45 degree fundus photograph · camera: NIDEK AFC-230: 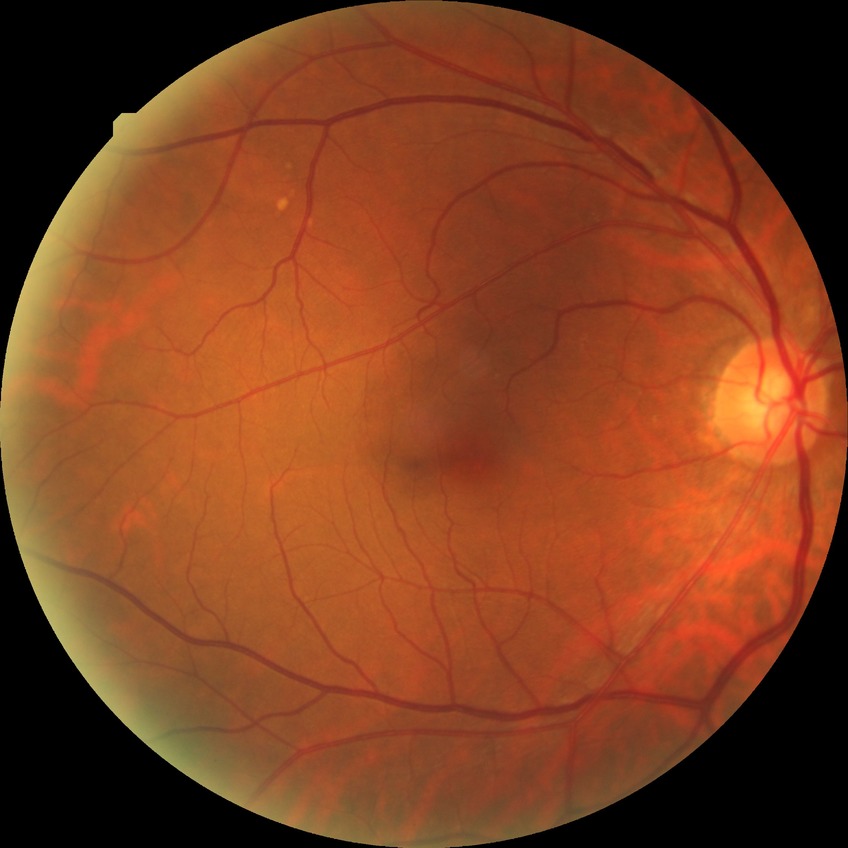
Diabetic retinopathy stage: no diabetic retinopathy.